45° field of view — 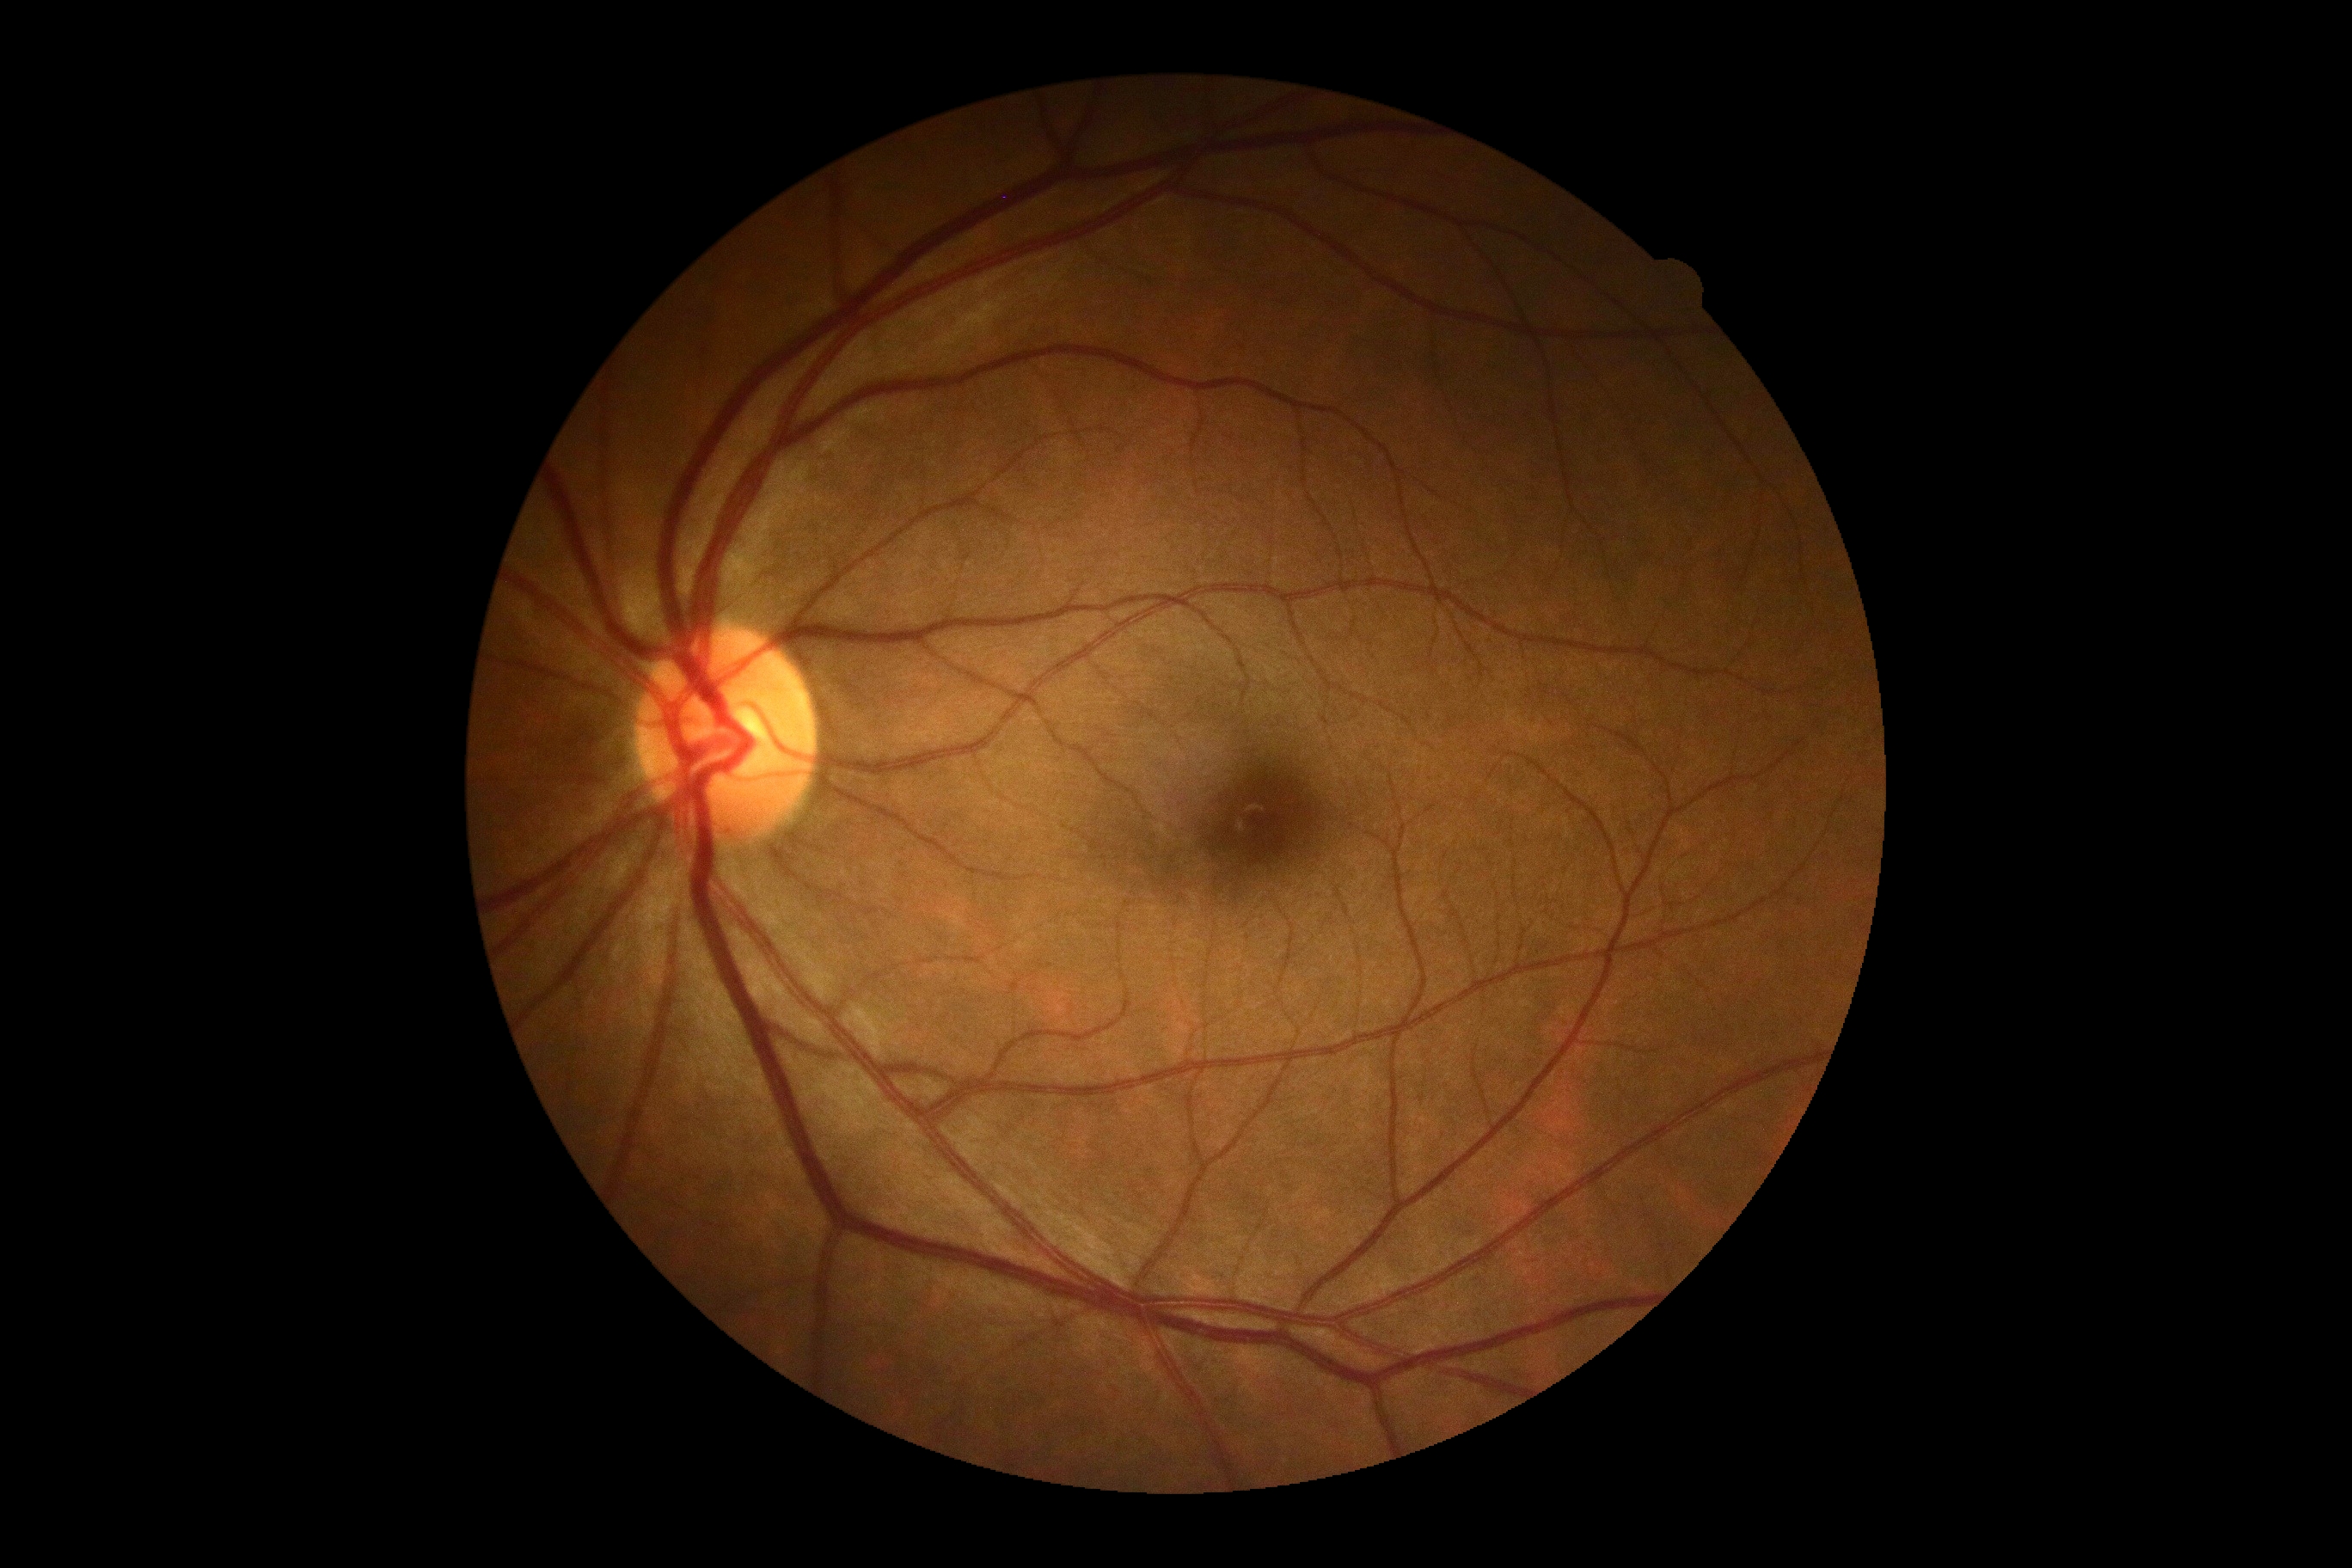
* DR: 0